Pediatric wide-field fundus photograph:
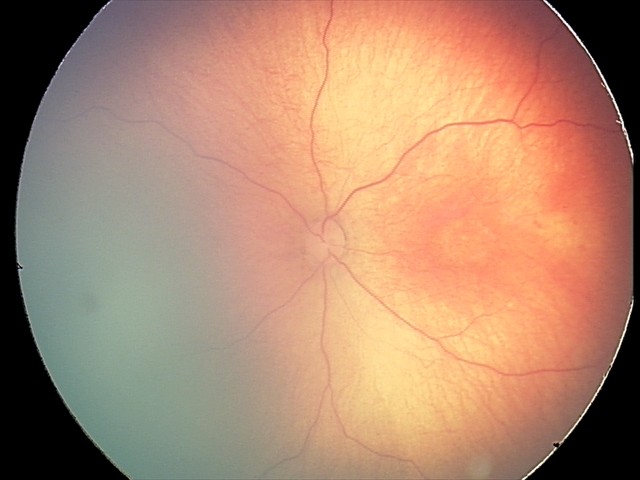

Screening series with retinal hemorrhages.